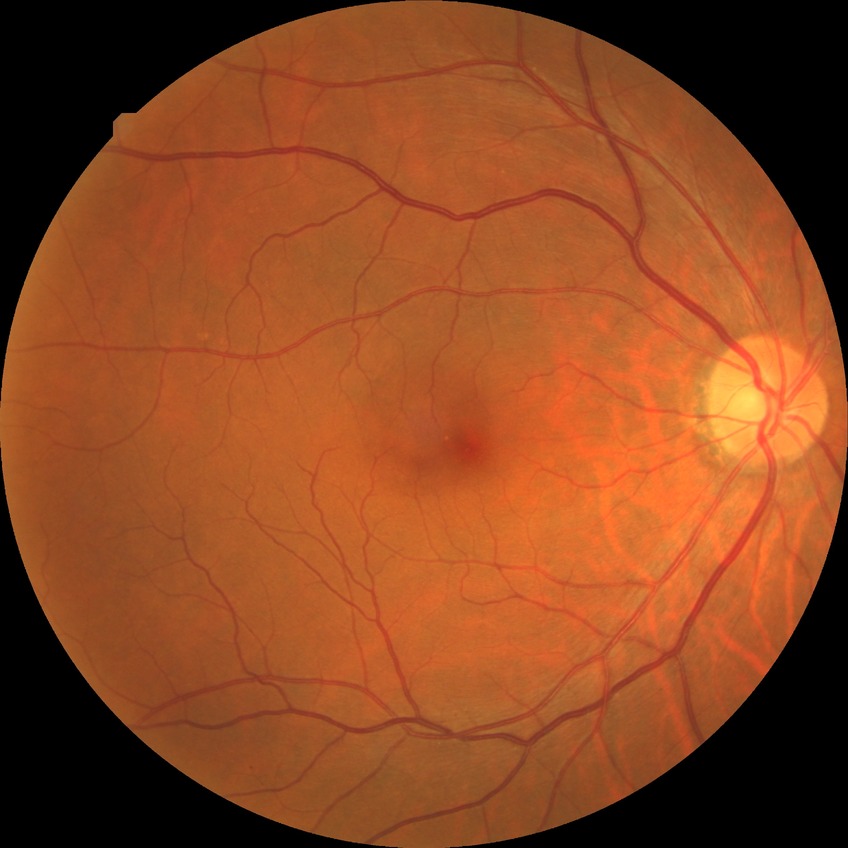 Diabetic retinopathy severity: no diabetic retinopathy.